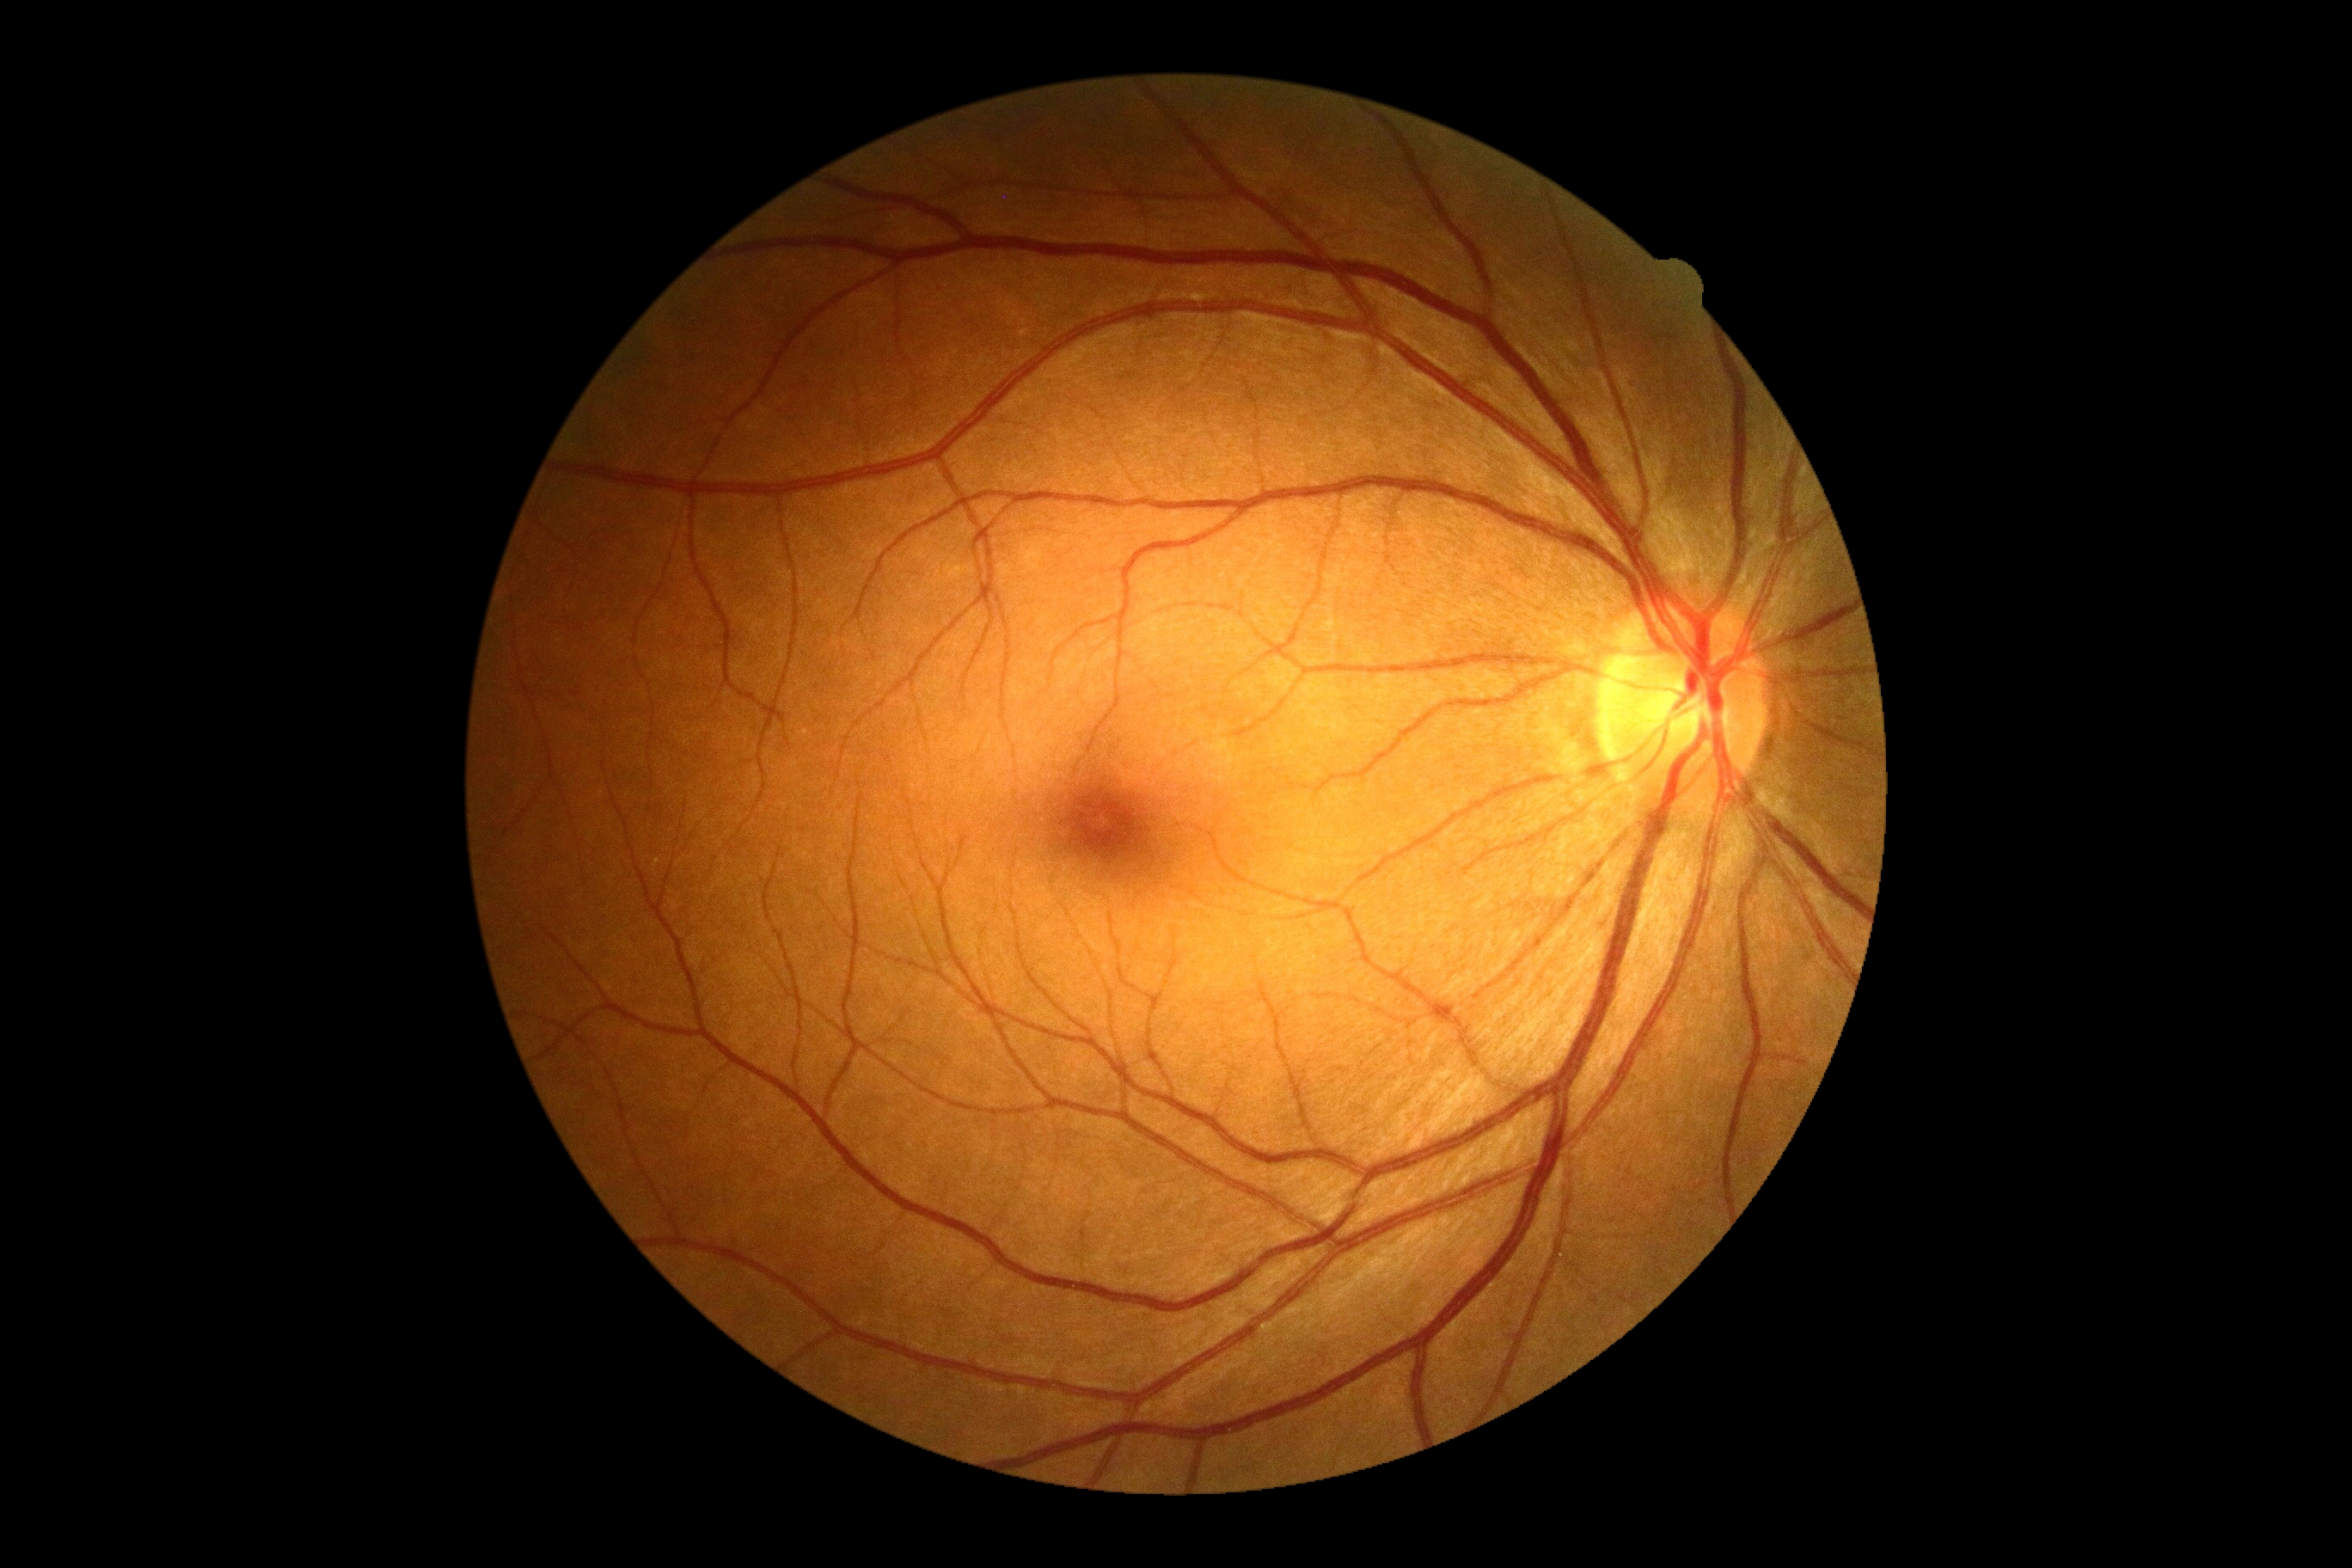

DR: no apparent retinopathy (grade 0) — no visible signs of diabetic retinopathy.